Intraocular pressure 17 mmHg by pneumatic tonometry · sex: female · undilated pupil · refractive error: +2.25 -0.5 × 70° · patient age: 46 years · captured on a Topcon TRC-NW400 fundus camera:
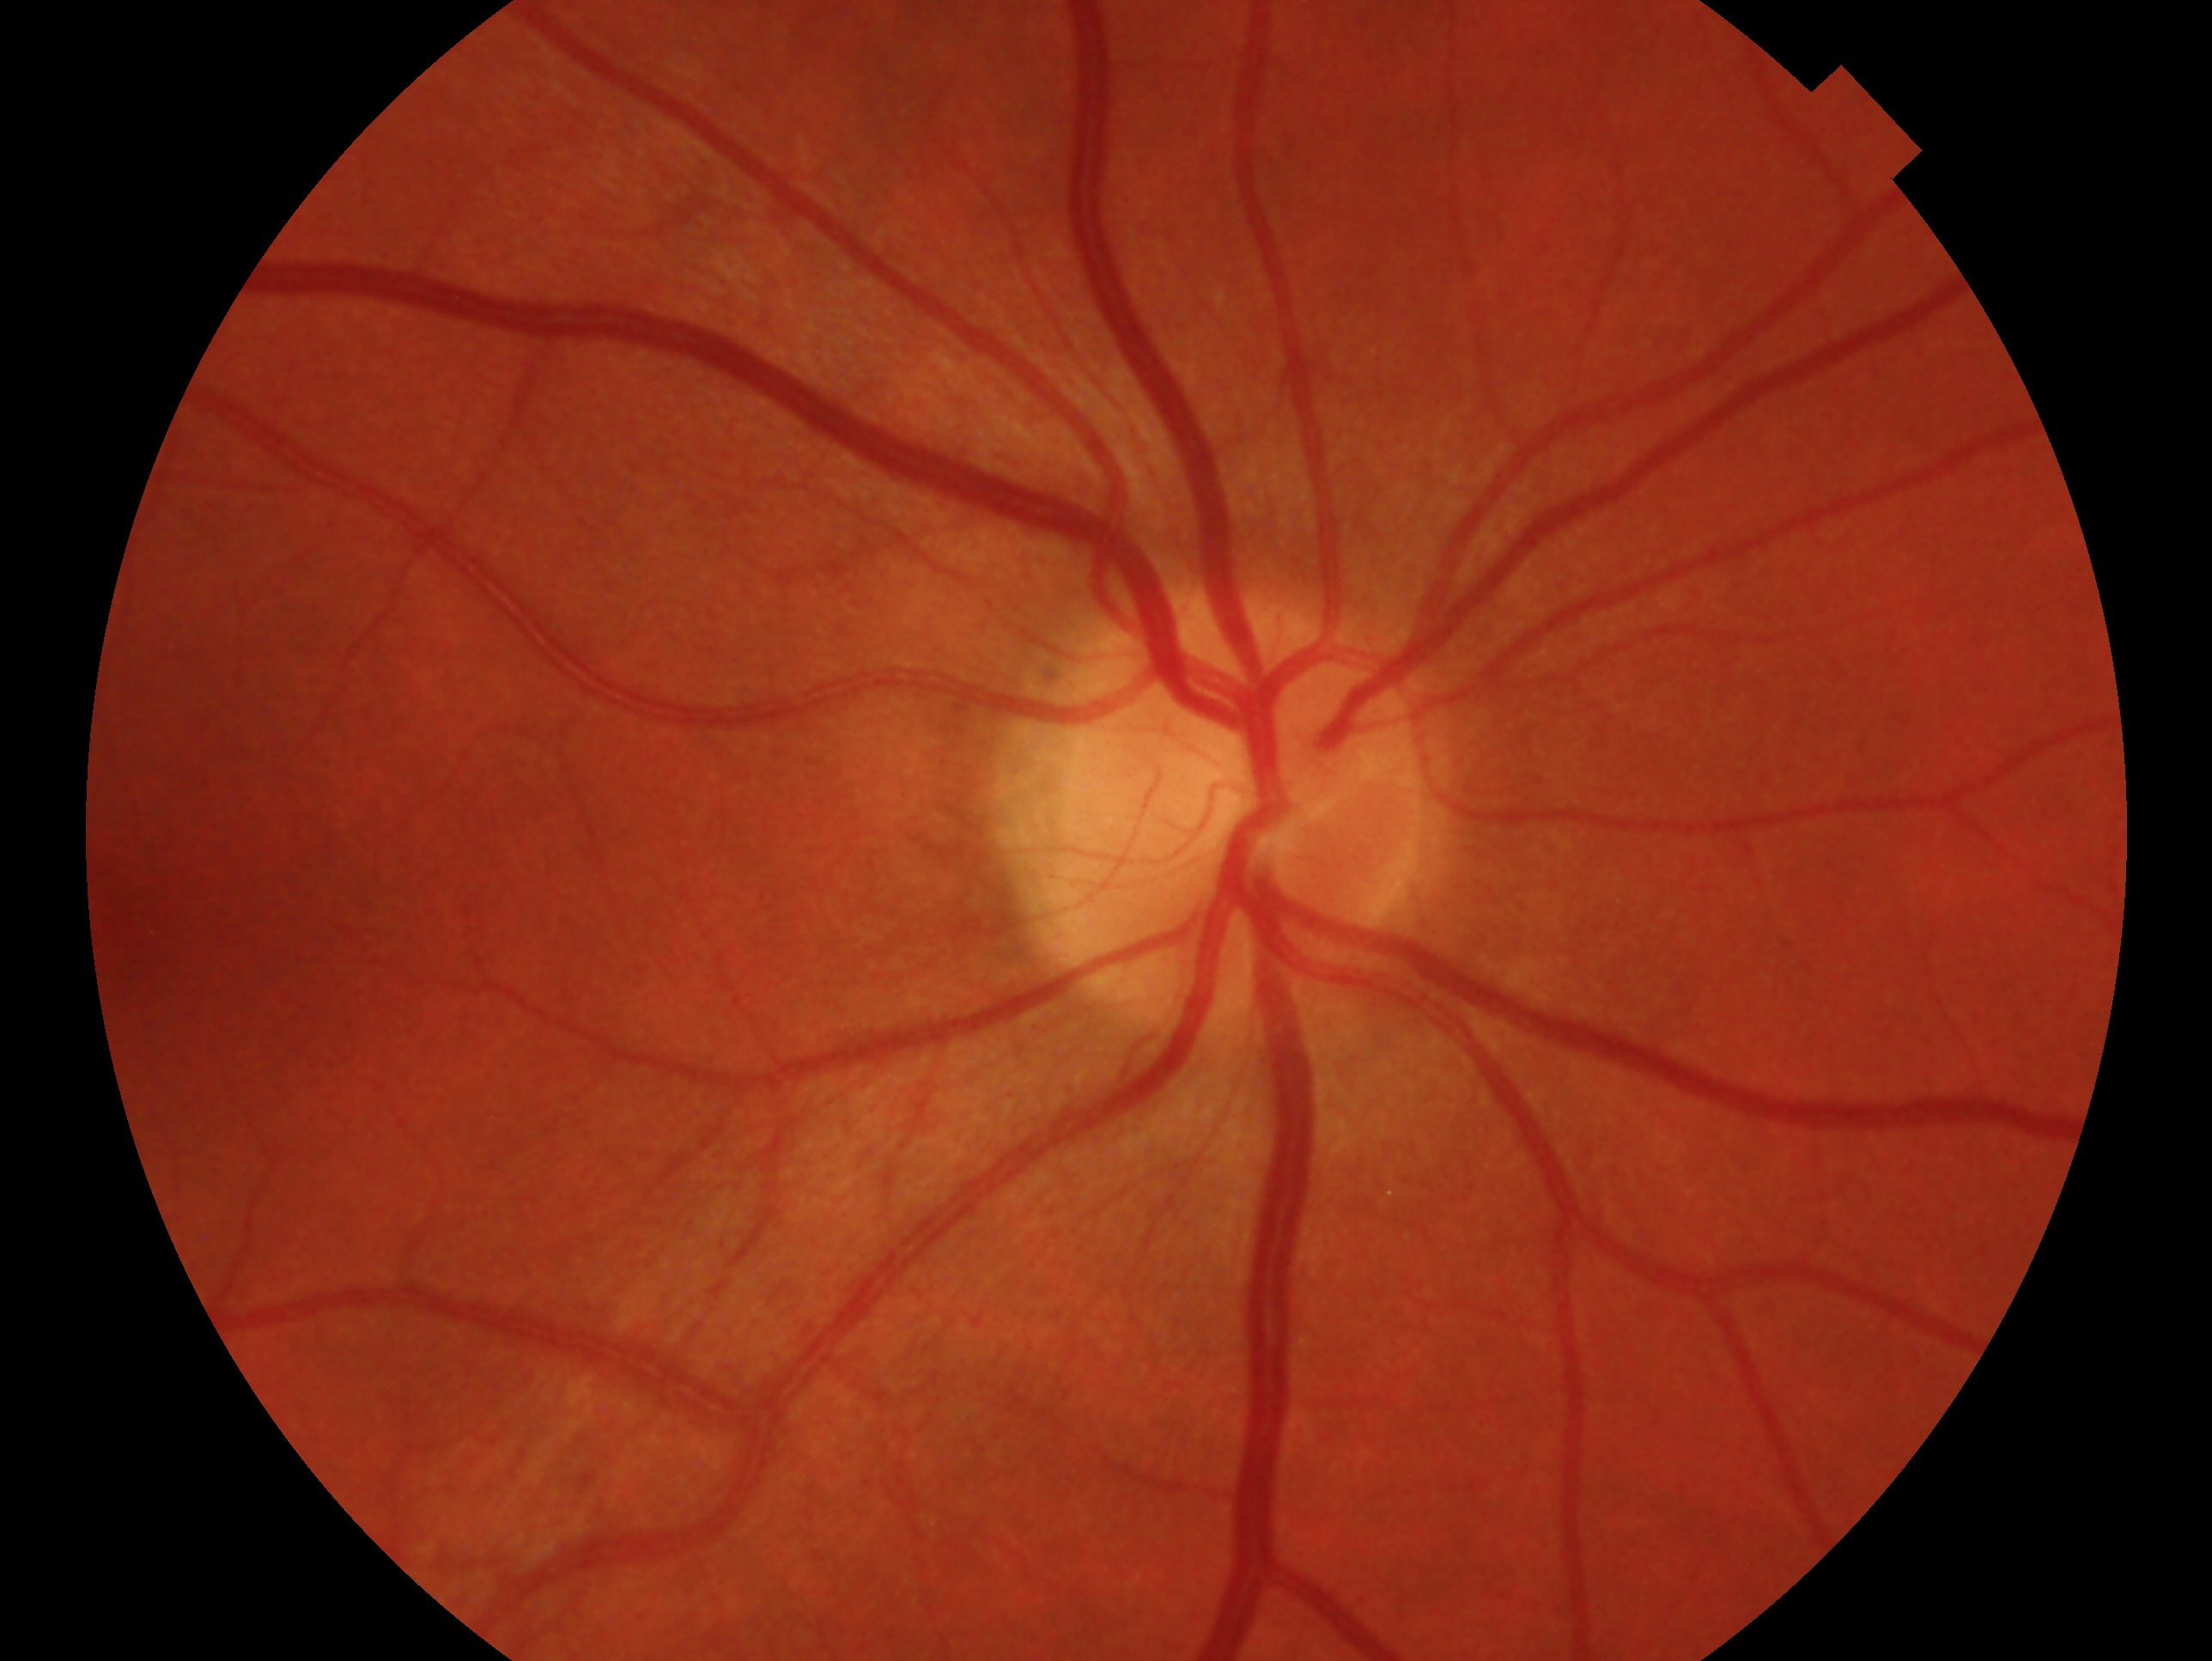 This is the oculus dexter. Glaucoma status: no signs of glaucoma.